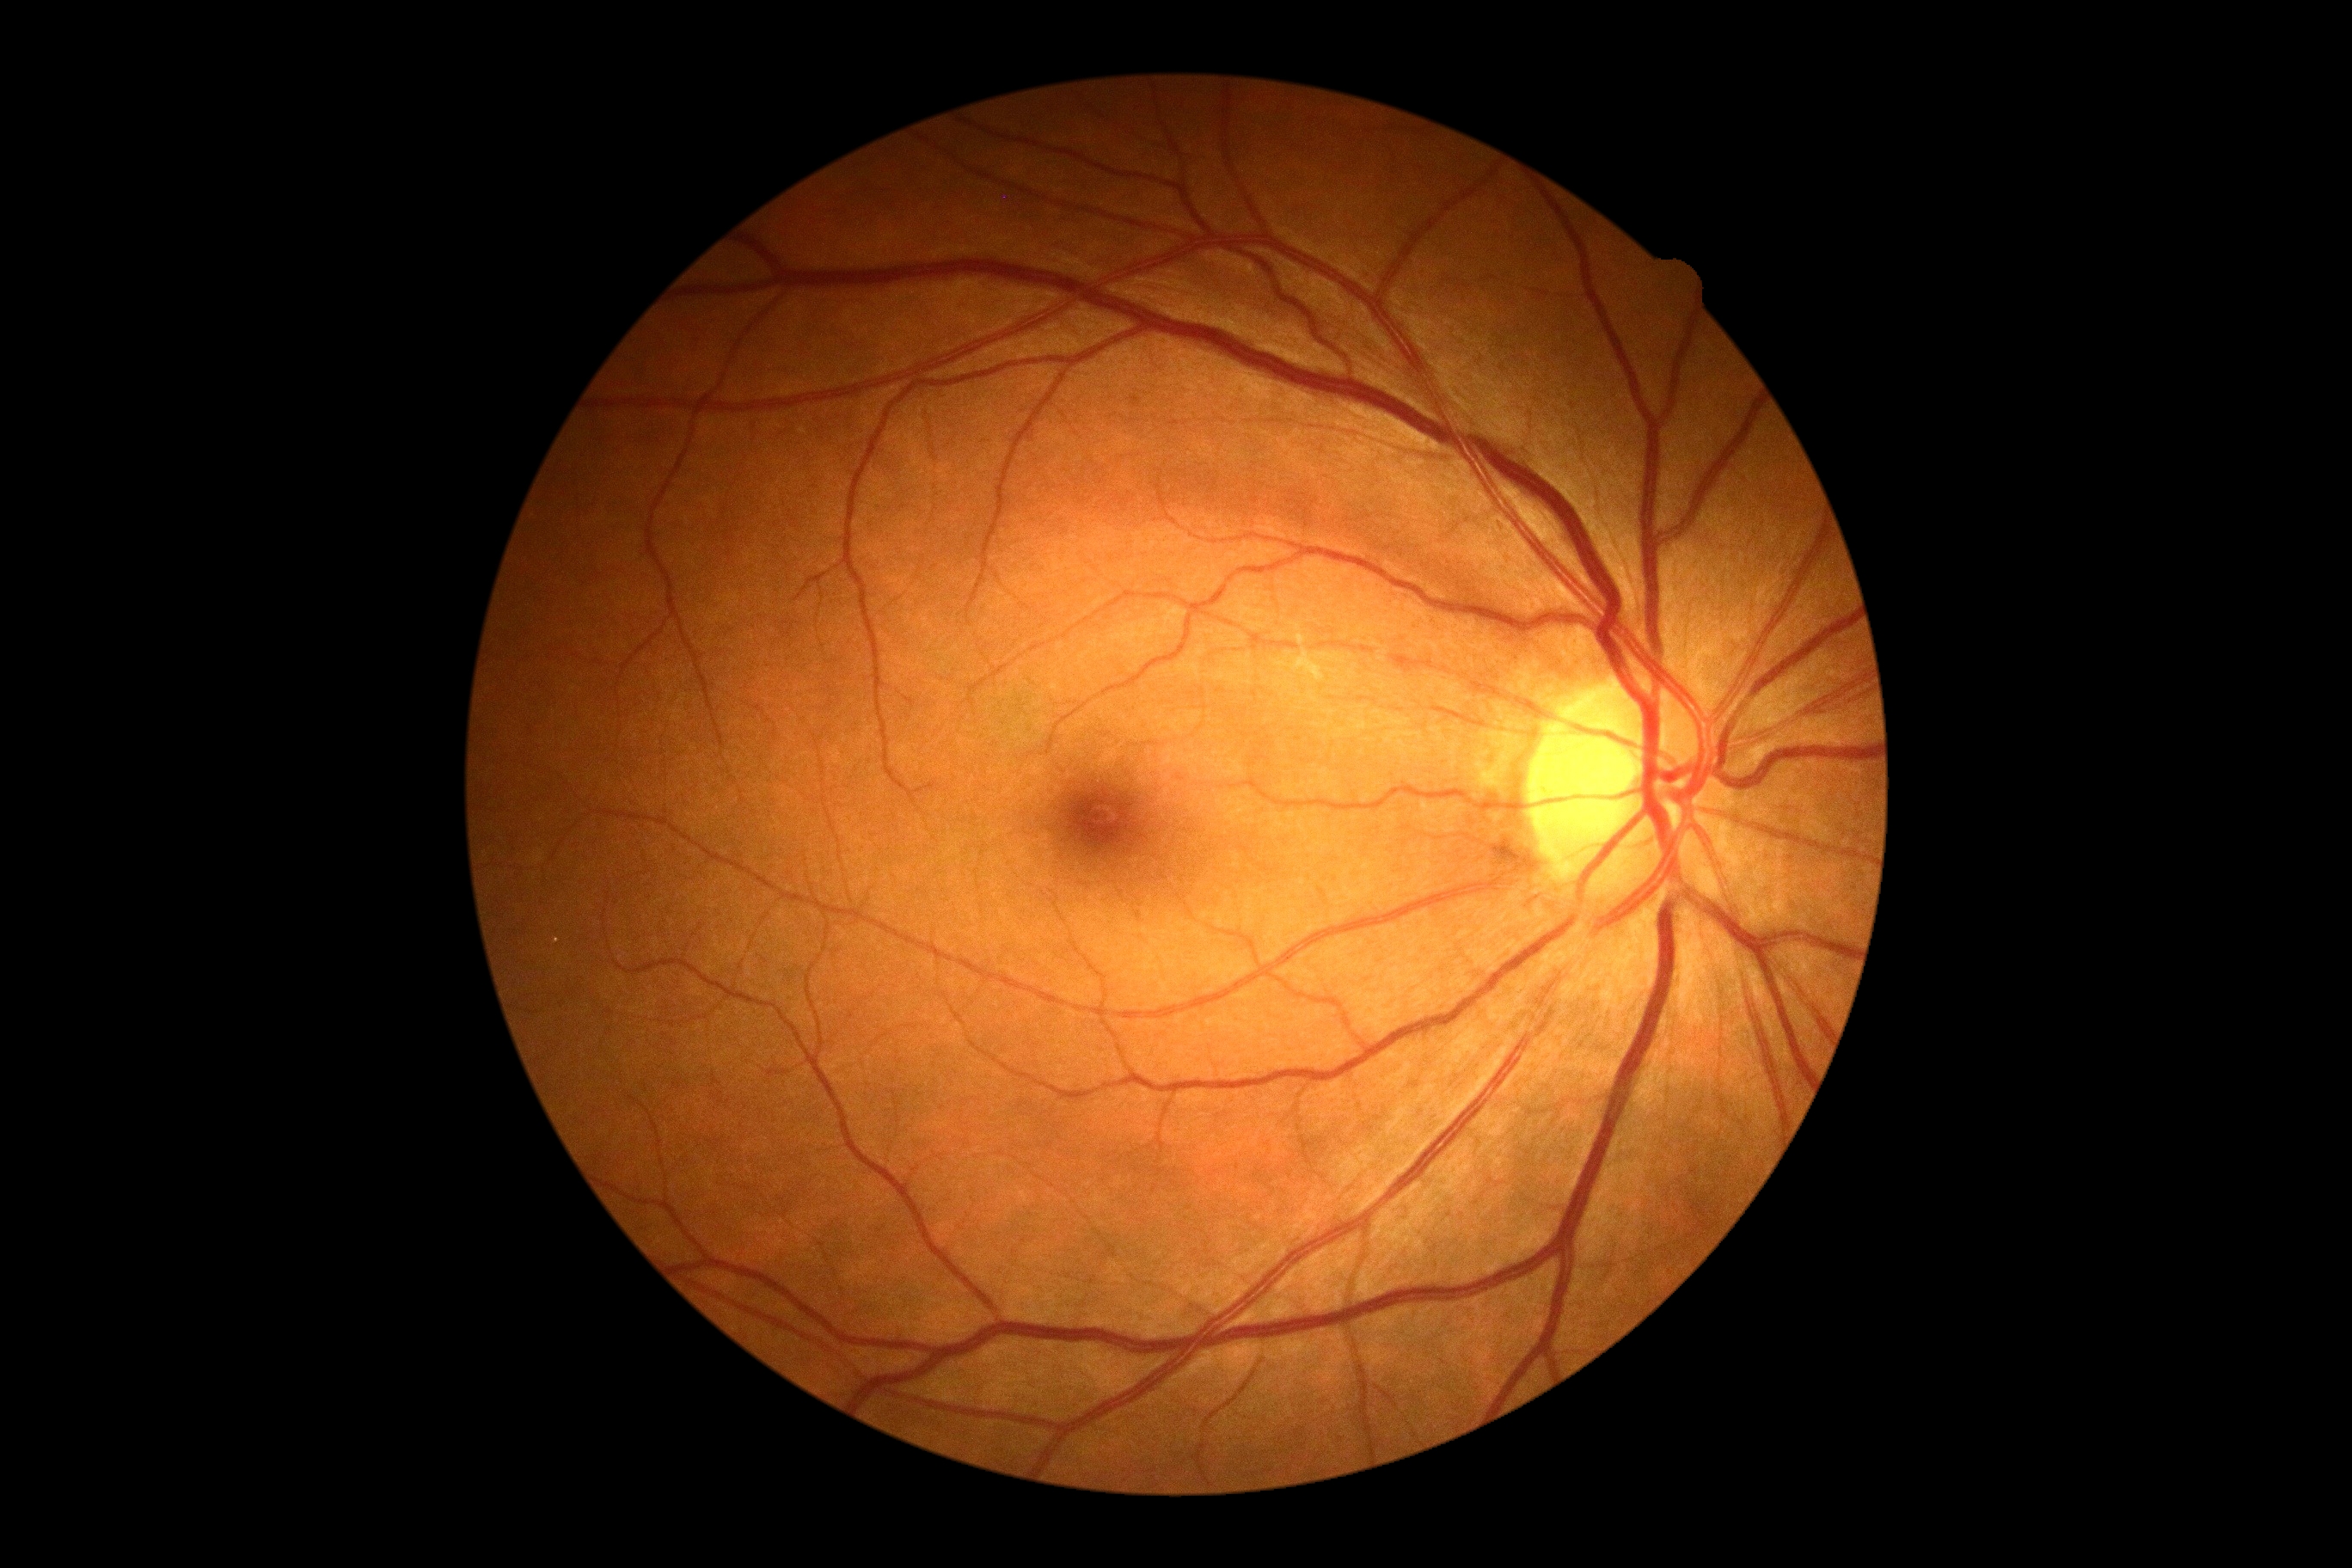

Diabetic retinopathy (DR) is grade 0.